FOV: 45 degrees — 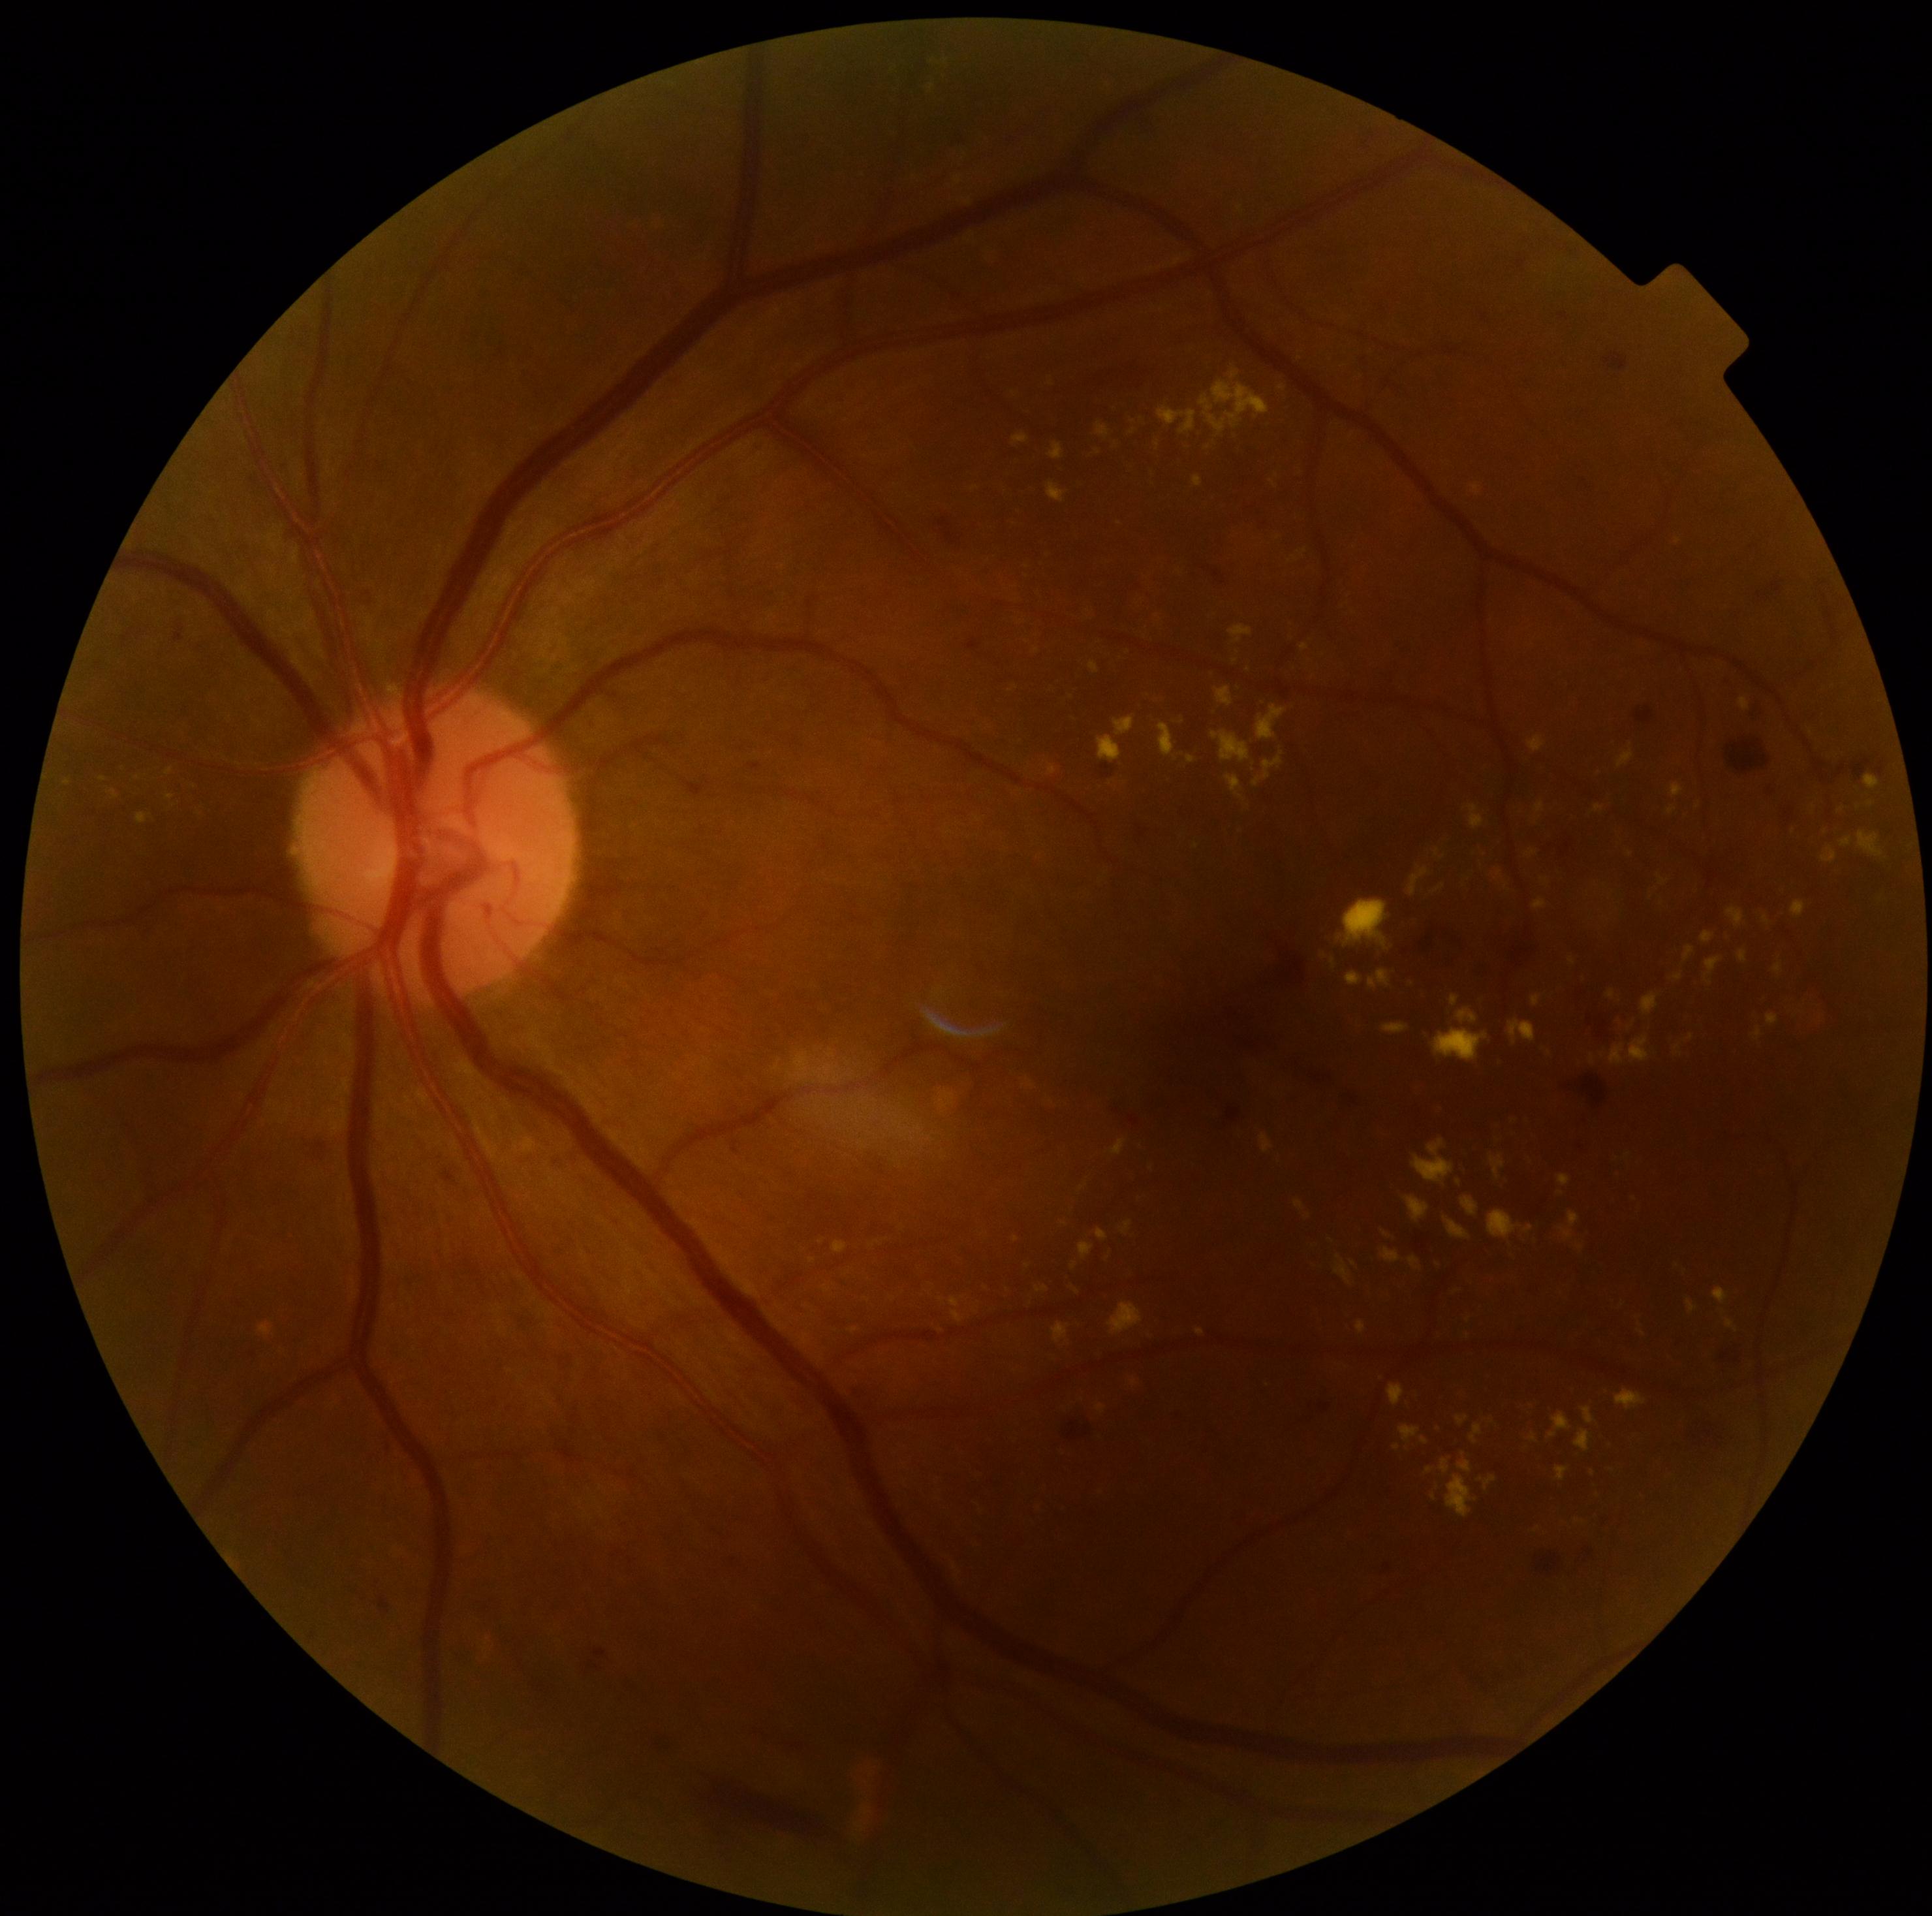

Diabetic retinopathy is grade 2 (moderate NPDR)
A subset of detected lesions:
- hard exudates (partial): [938,1090,956,1111]; [1822,846,1837,863]; [1054,1323,1070,1343]; [1156,441,1160,449]; [1383,1231,1391,1238]; [138,812,151,824]; [1433,1029,1490,1063]; [1451,995,1460,1007]; [1704,958,1721,986]; [1857,830,1883,856]; [110,790,119,799]; [1472,1423,1482,1444]; [1300,550,1307,558]; [1559,1174,1570,1187]
- Small hard exudates approximately at (x=1766, y=920); (x=1111, y=783); (x=1099, y=452); (x=1027, y=1266)